FOV: 45 degrees
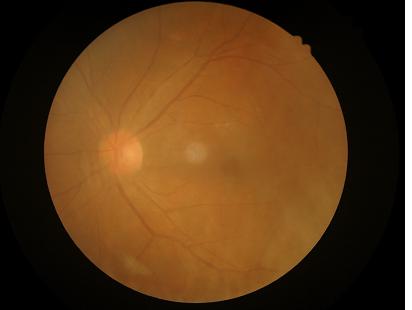
overall_quality: inadequate
clarity: poor
illumination: adequate
contrast: adequate